Cropped to the optic nerve head:
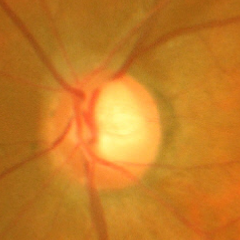 Optic disc appearance consistent with severe glaucomatous damage. Diagnostic criteria: near-total cupping of the optic nerve head, with or without severe visual field loss within the central 10 degrees of fixation.